45-degree field of view, fundus photo, 2048 by 1536 pixels:
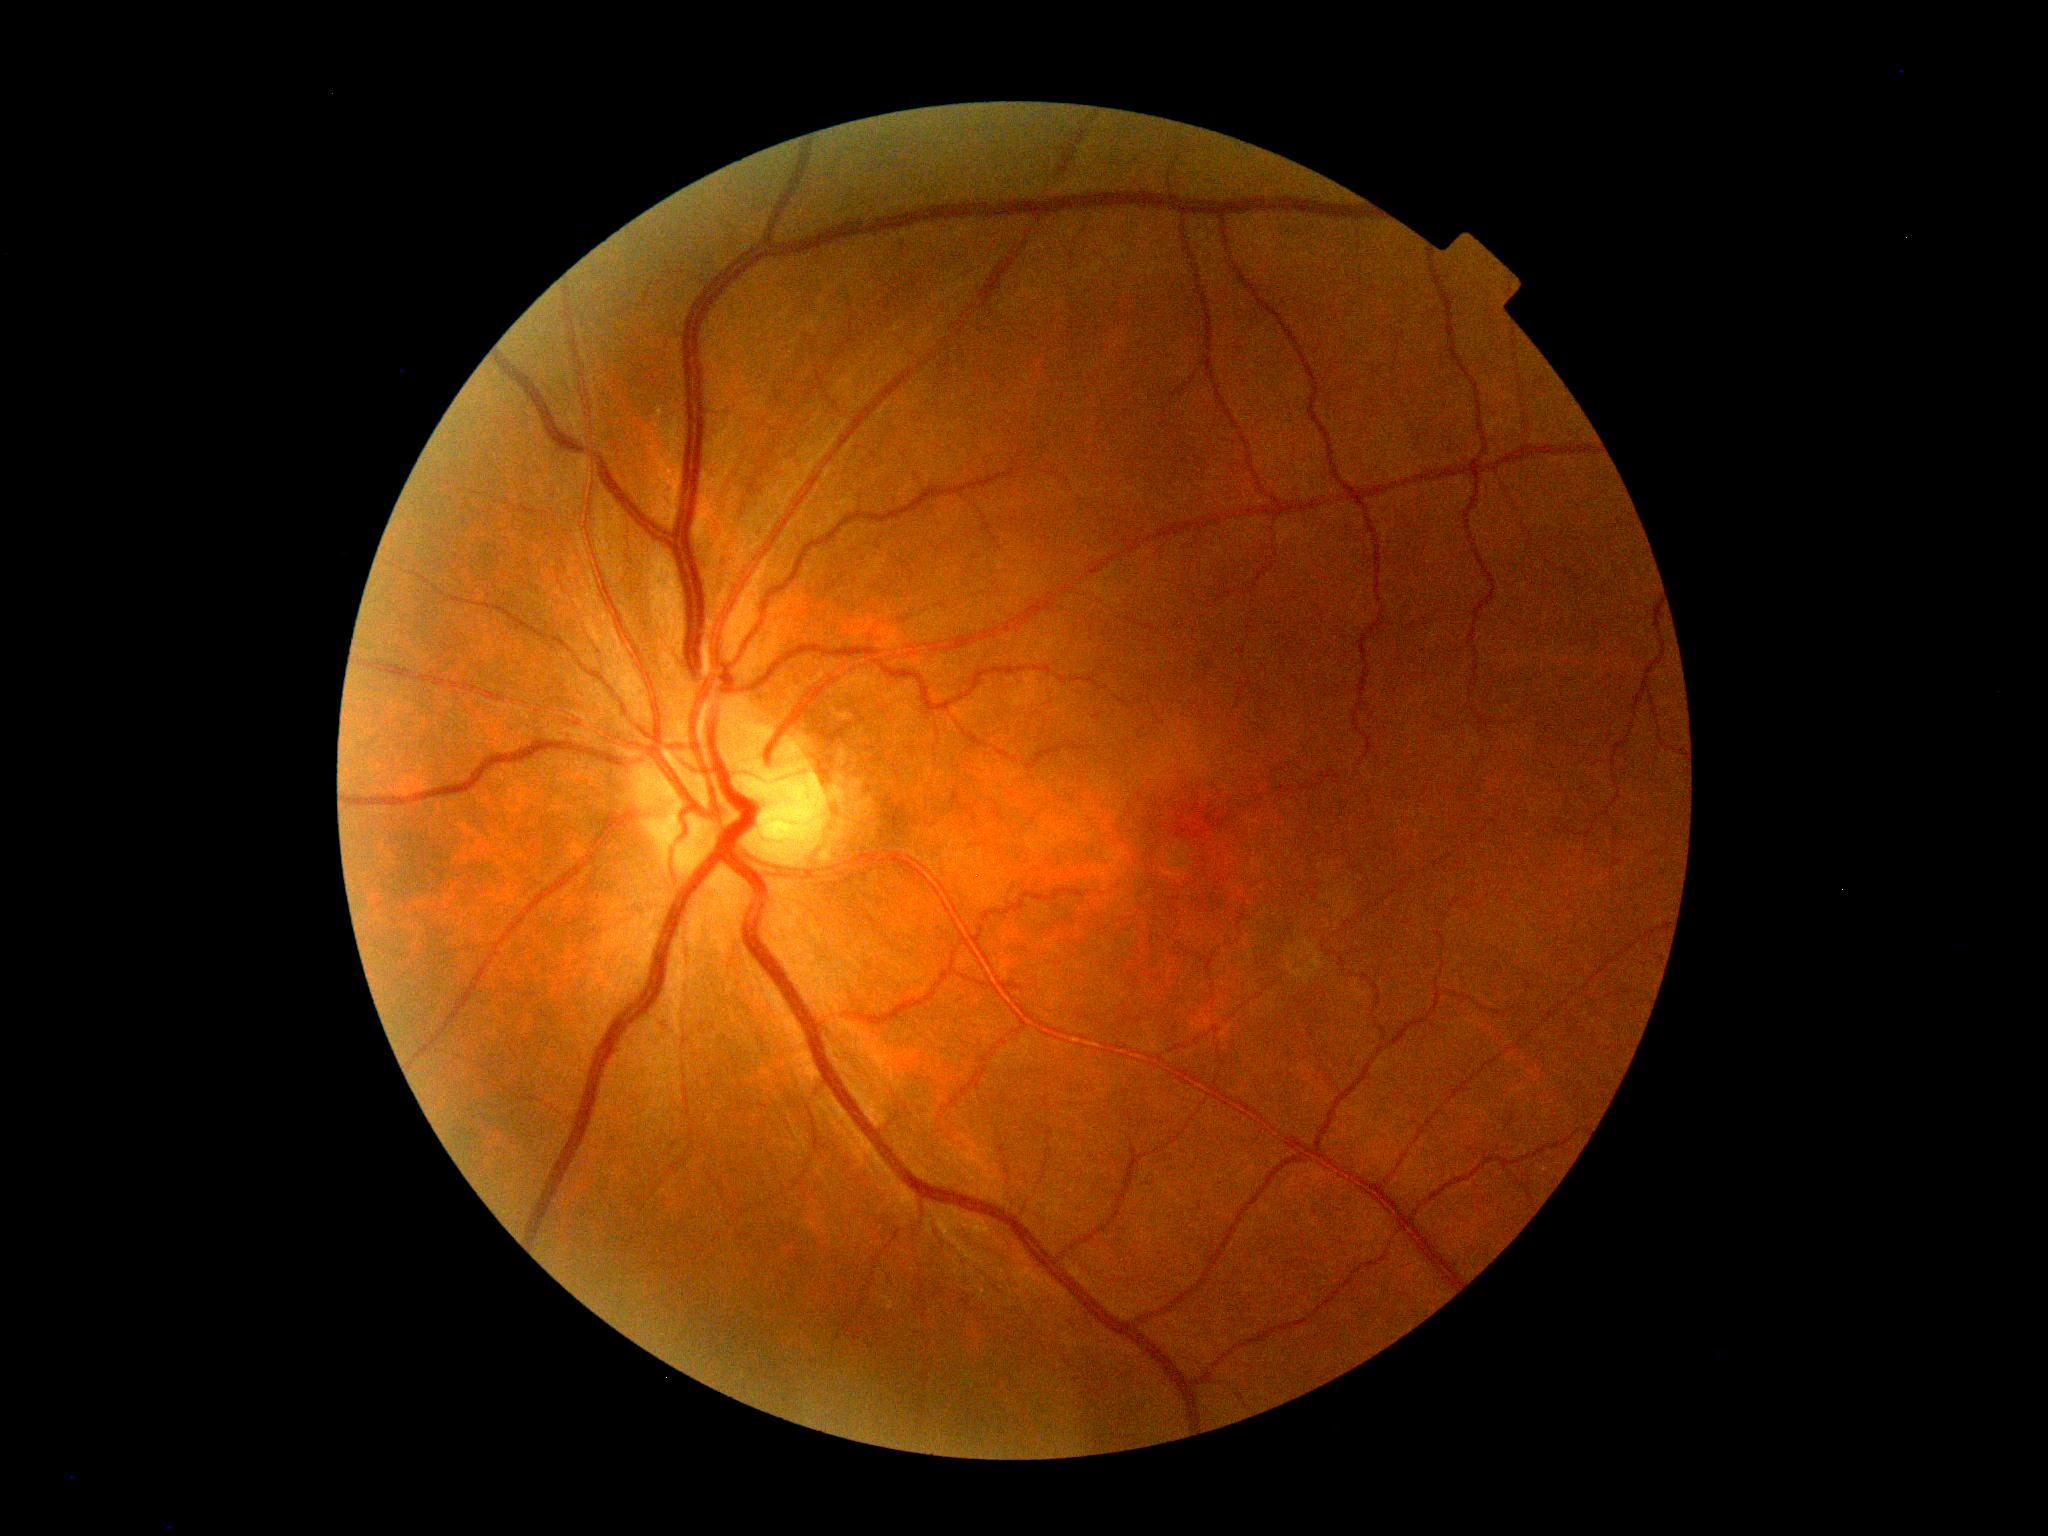

Diabetic retinopathy severity is no apparent diabetic retinopathy (grade 0).